Posterior pole color fundus photograph, diabetic retinopathy graded by the modified Davis classification
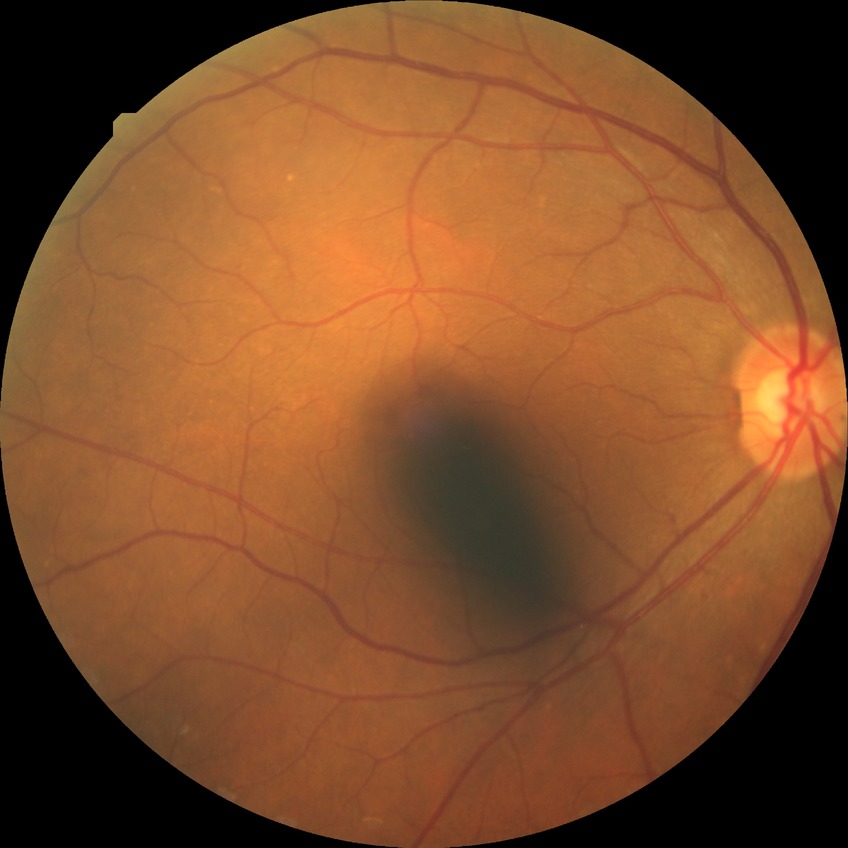

Diabetic retinopathy (DR): NDR (no diabetic retinopathy).